2212 by 1659 pixels · 45° field of view · fundus photo:
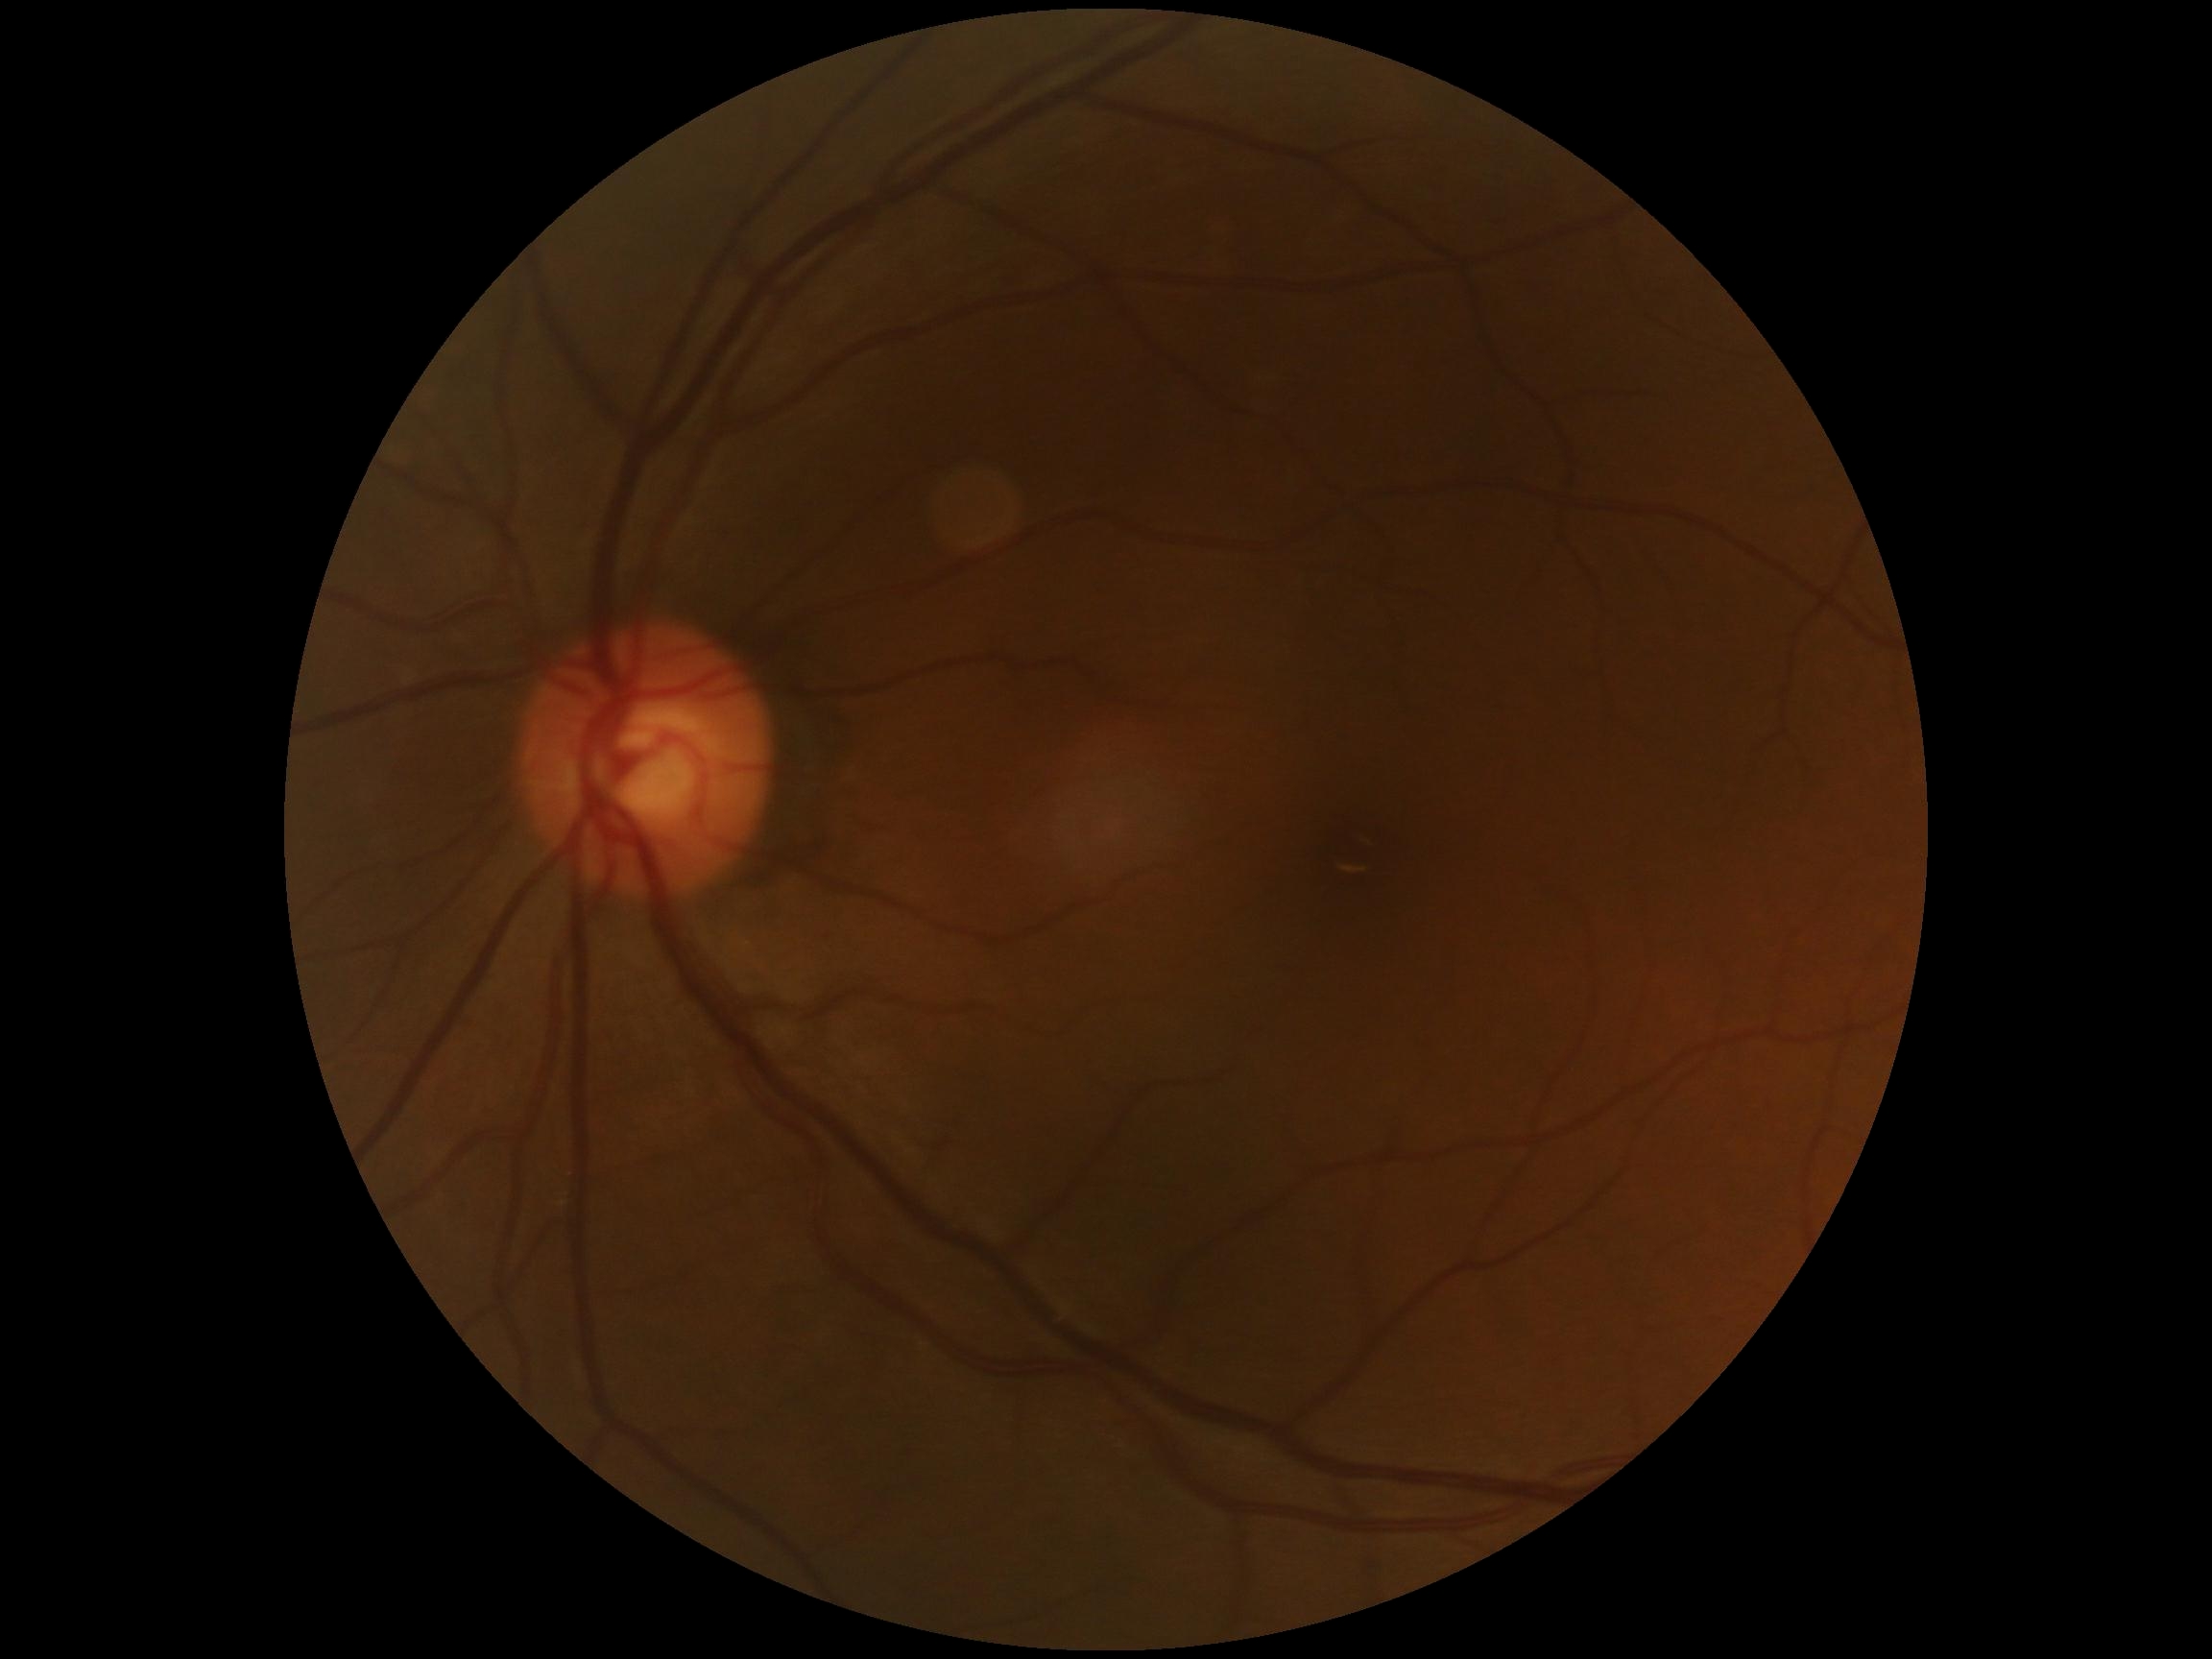

Retinopathy grade is 0 (no apparent retinopathy).